Without pupil dilation; 45-degree field of view
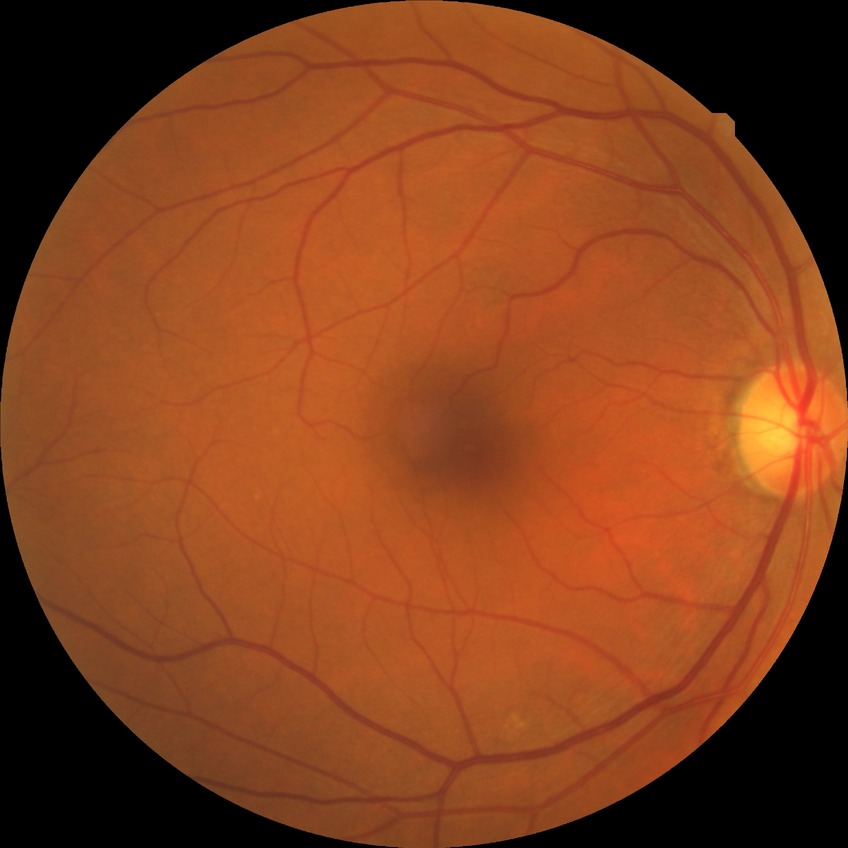   davis_grade: no diabetic retinopathy